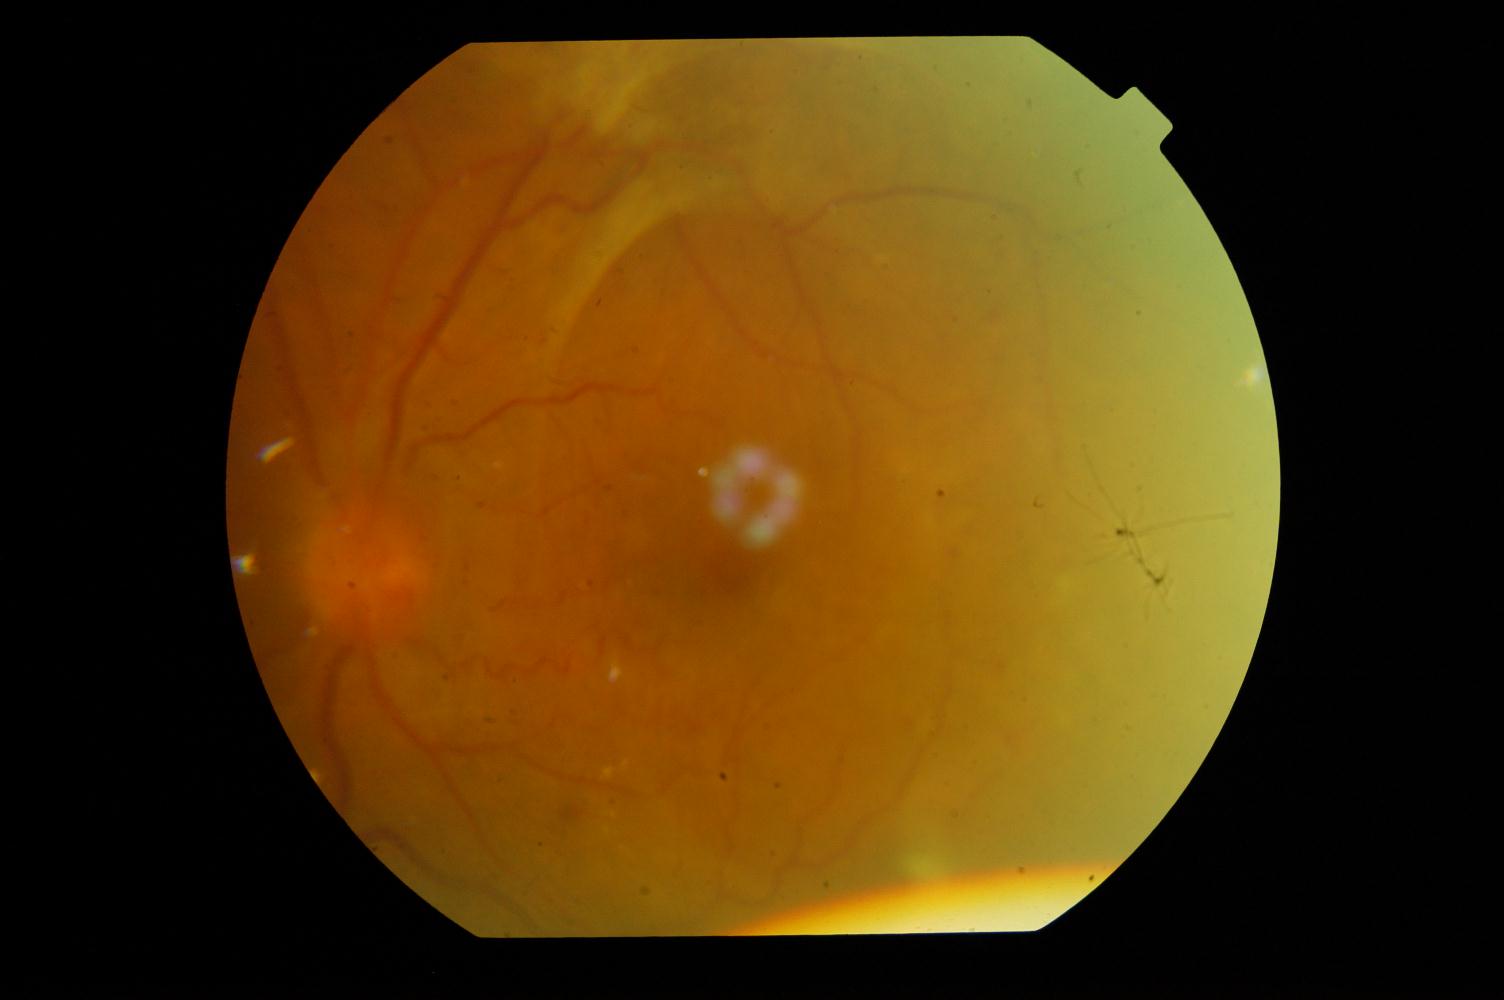
Impression:
- diabetic retinopathy